2228x1652. FOV: 50 degrees
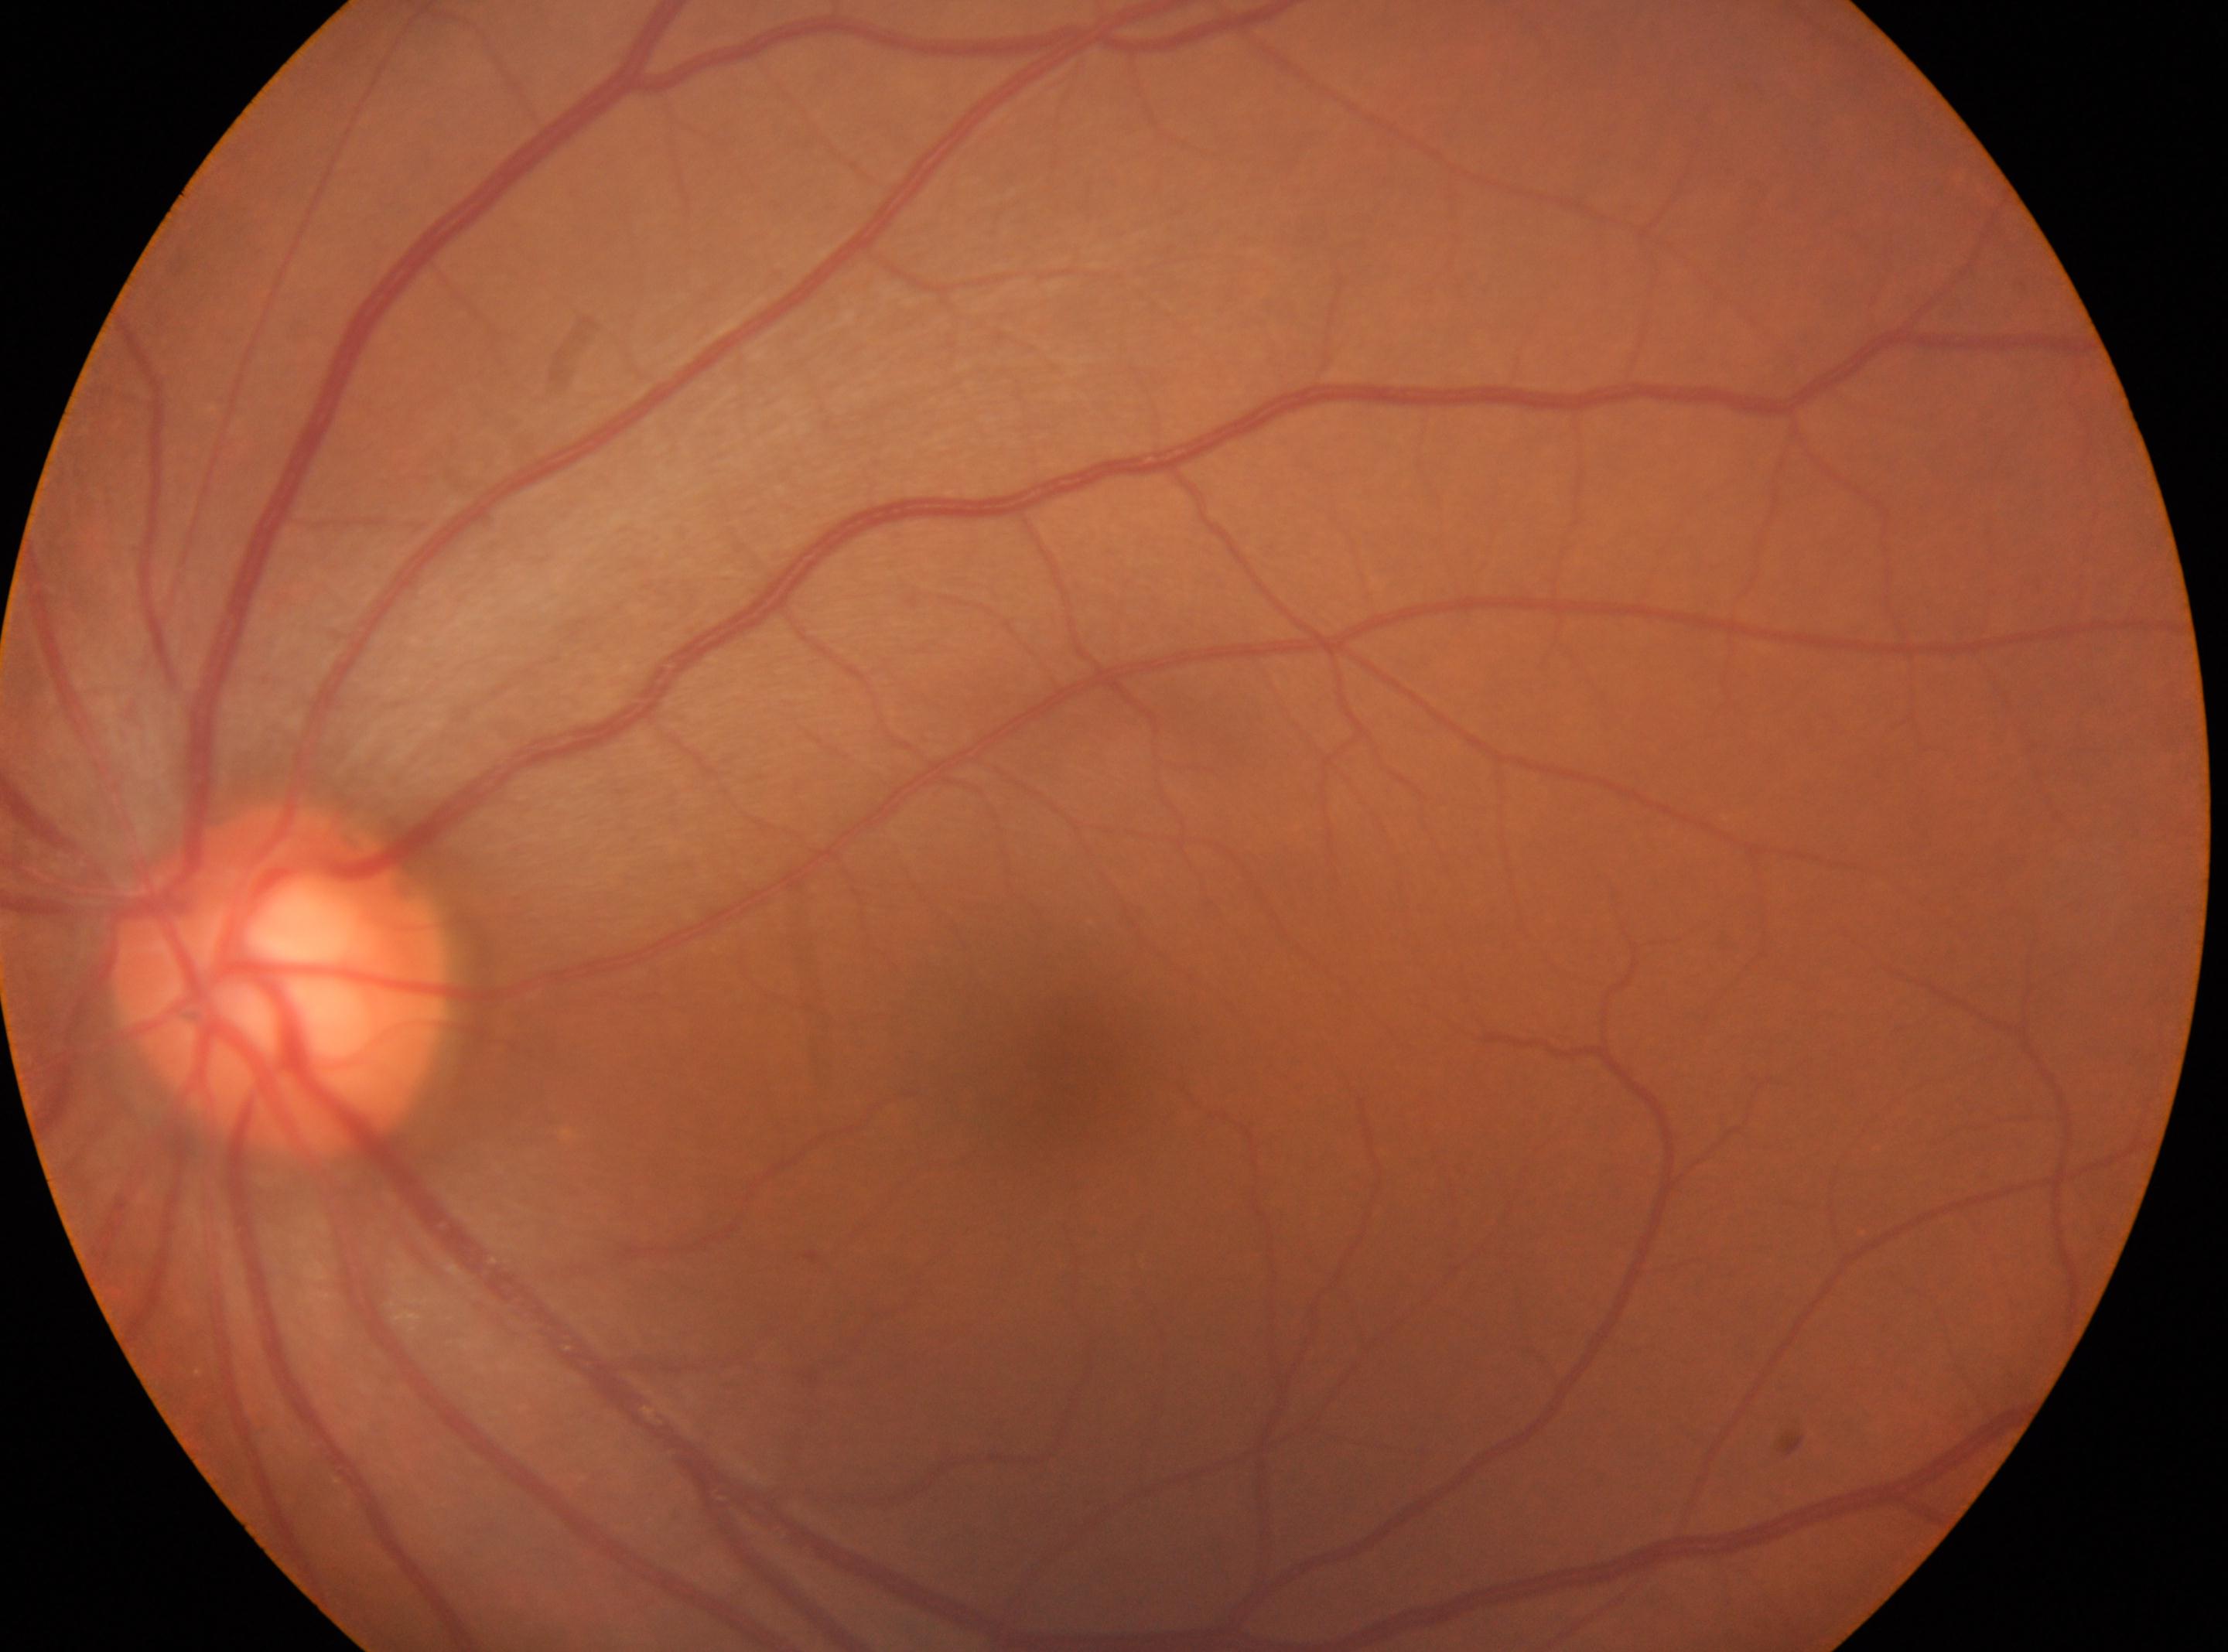 optic nerve head: 280px, 982px
laterality: oculus sinister
diabetic retinopathy: no apparent retinopathy (grade 0)
fovea: 1063px, 1052px